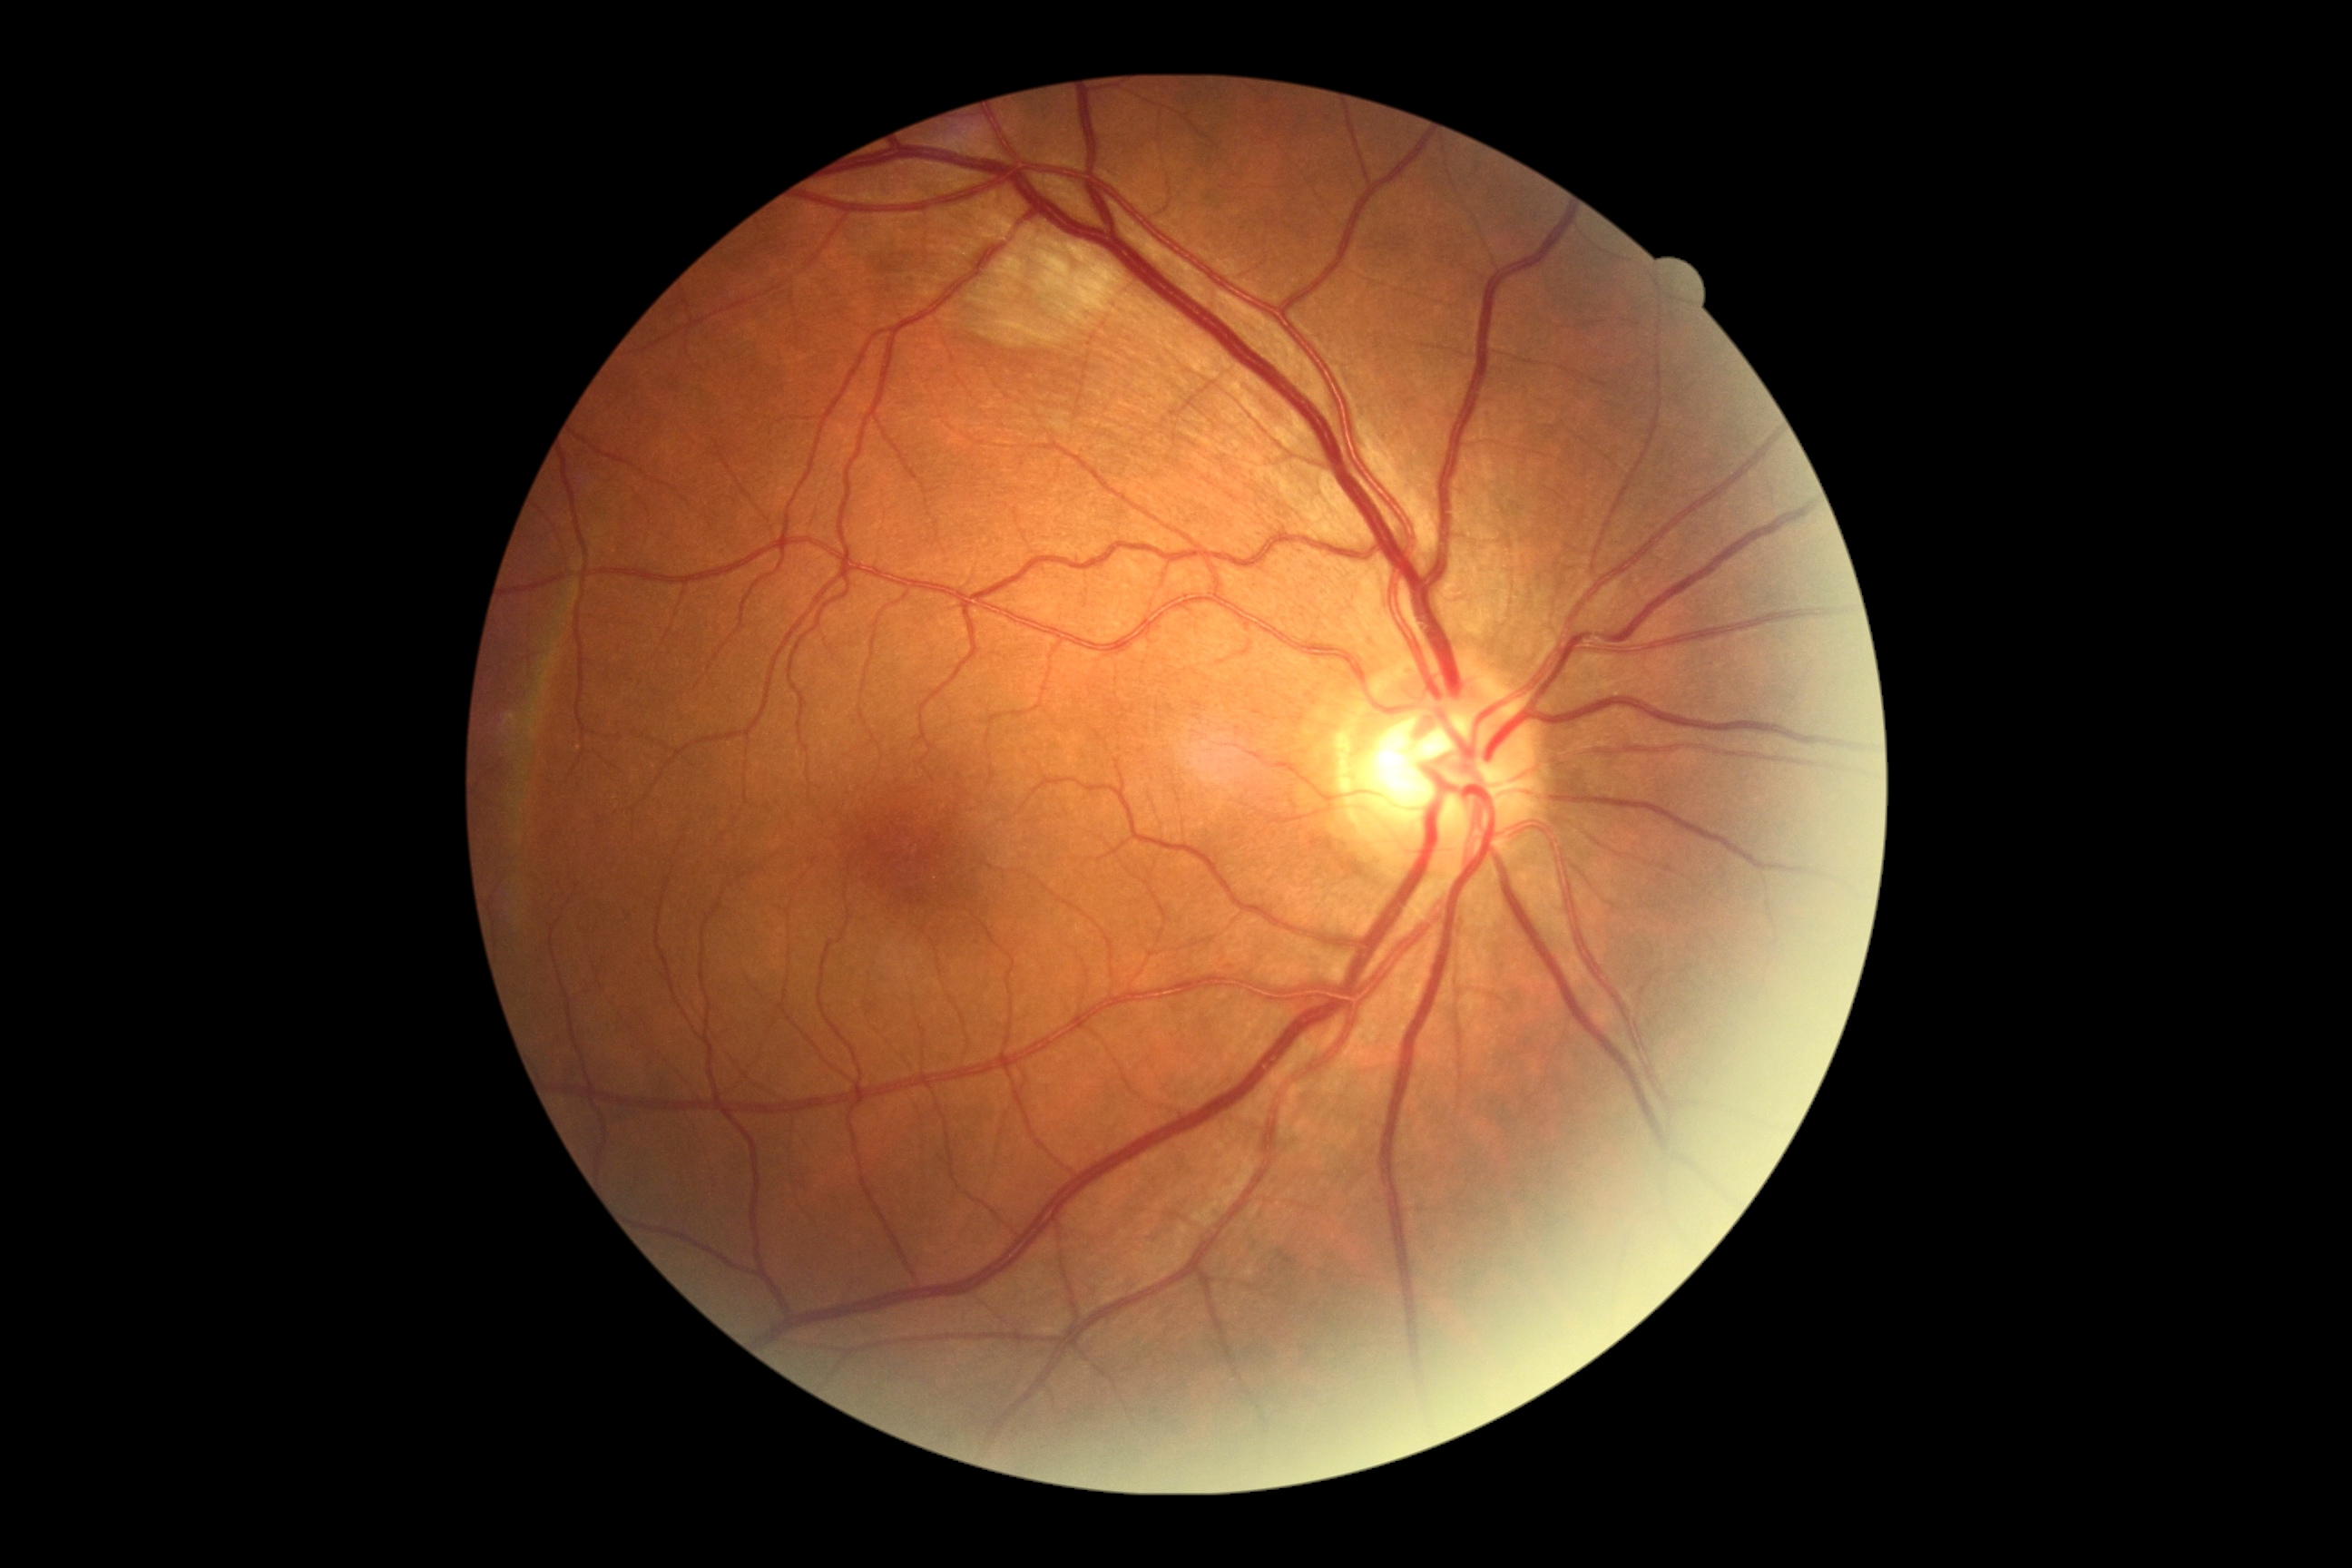 retinopathy = moderate NPDR (grade 2), DR class = non-proliferative diabetic retinopathy.